Infant wide-field fundus photograph · captured with the Phoenix ICON (100° field of view)
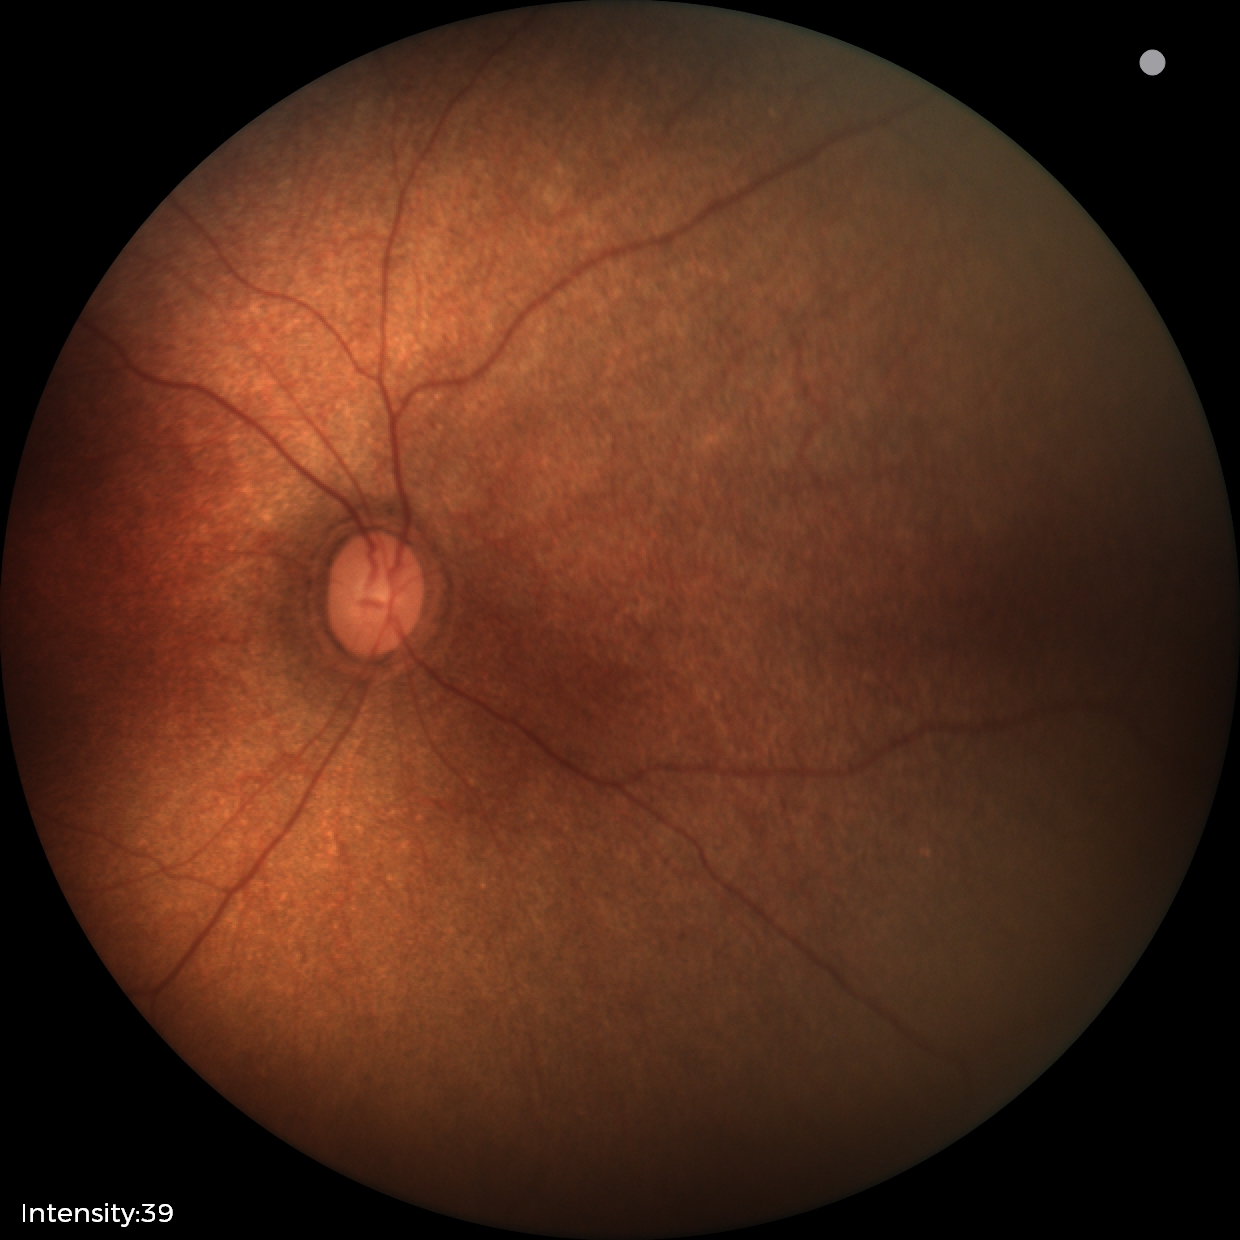

Q: What was the screening finding?
A: no abnormal retinal findings